Wide-field contact fundus photograph of an infant. Image size 640x480: 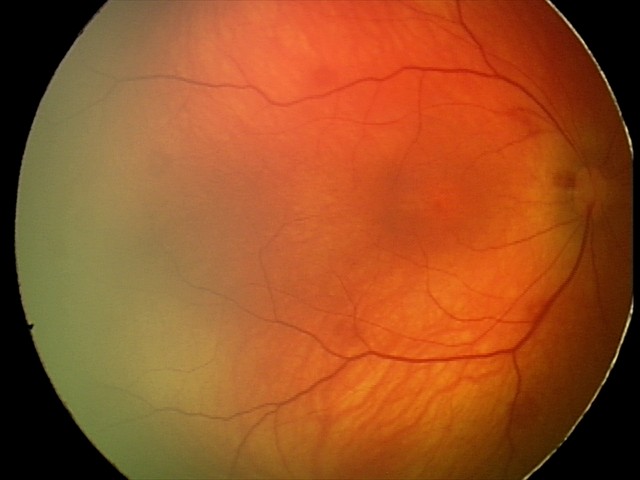 Impression = retinal hemorrhages